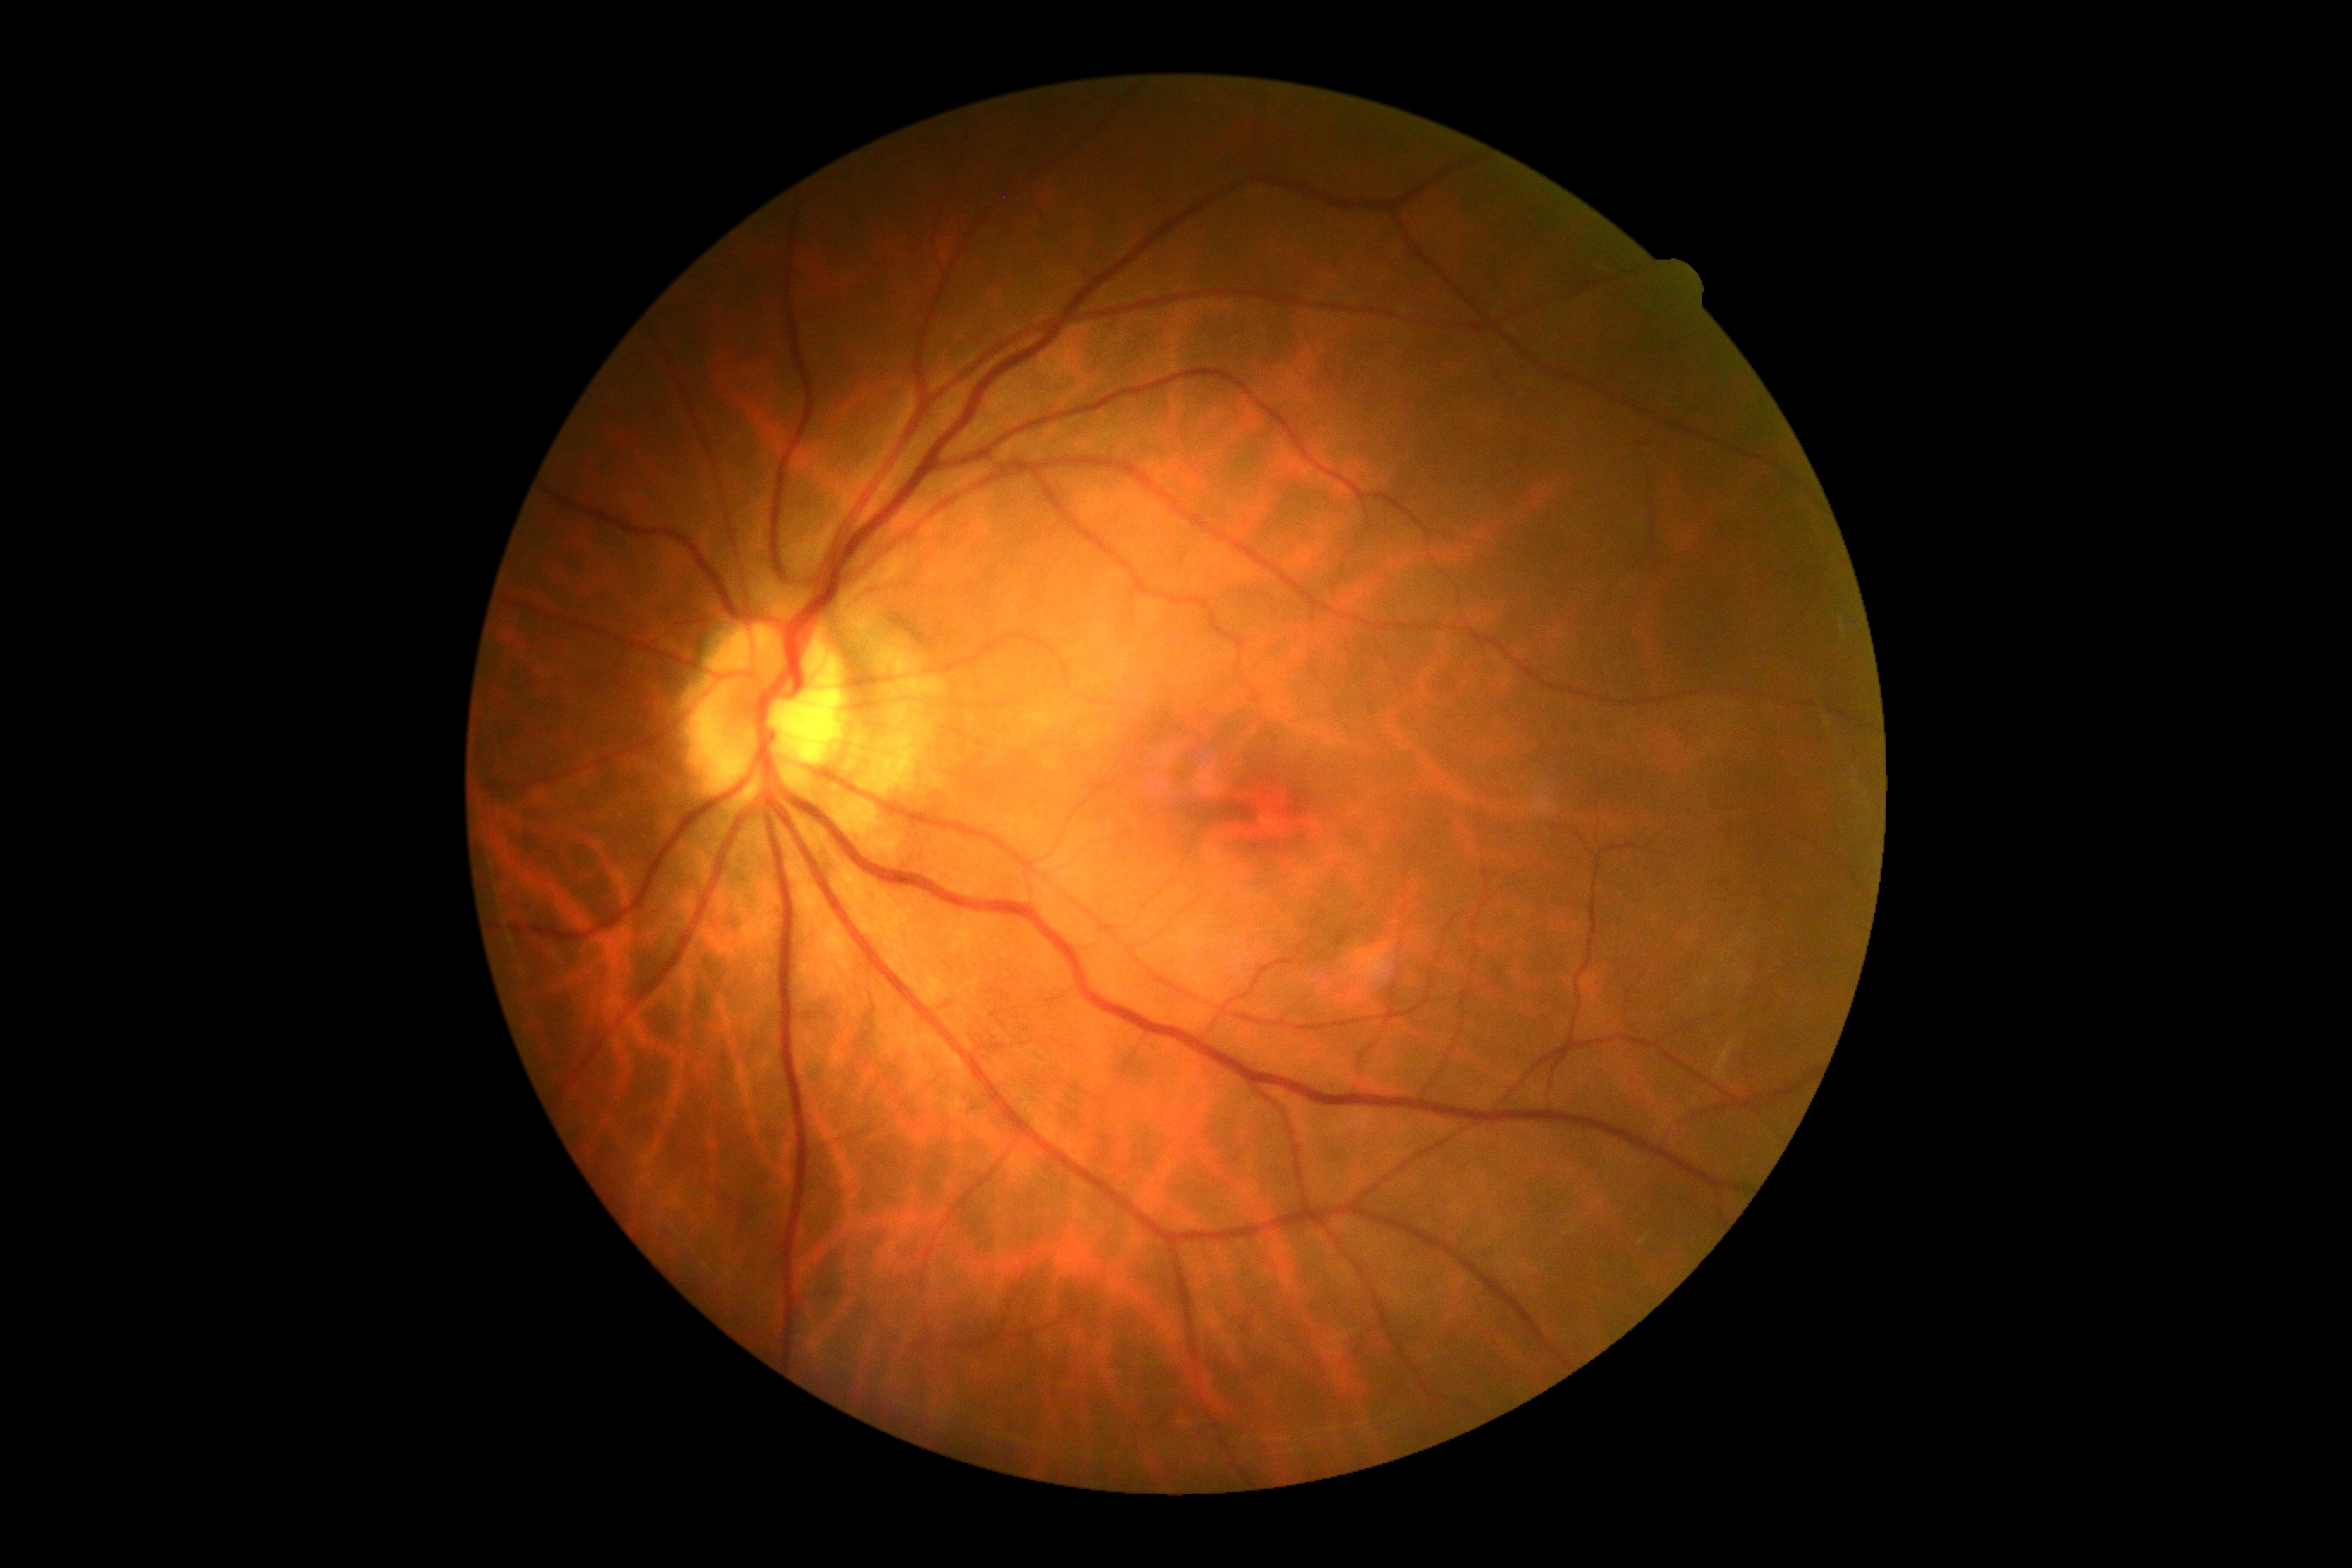

diabetic retinopathy severity=0.